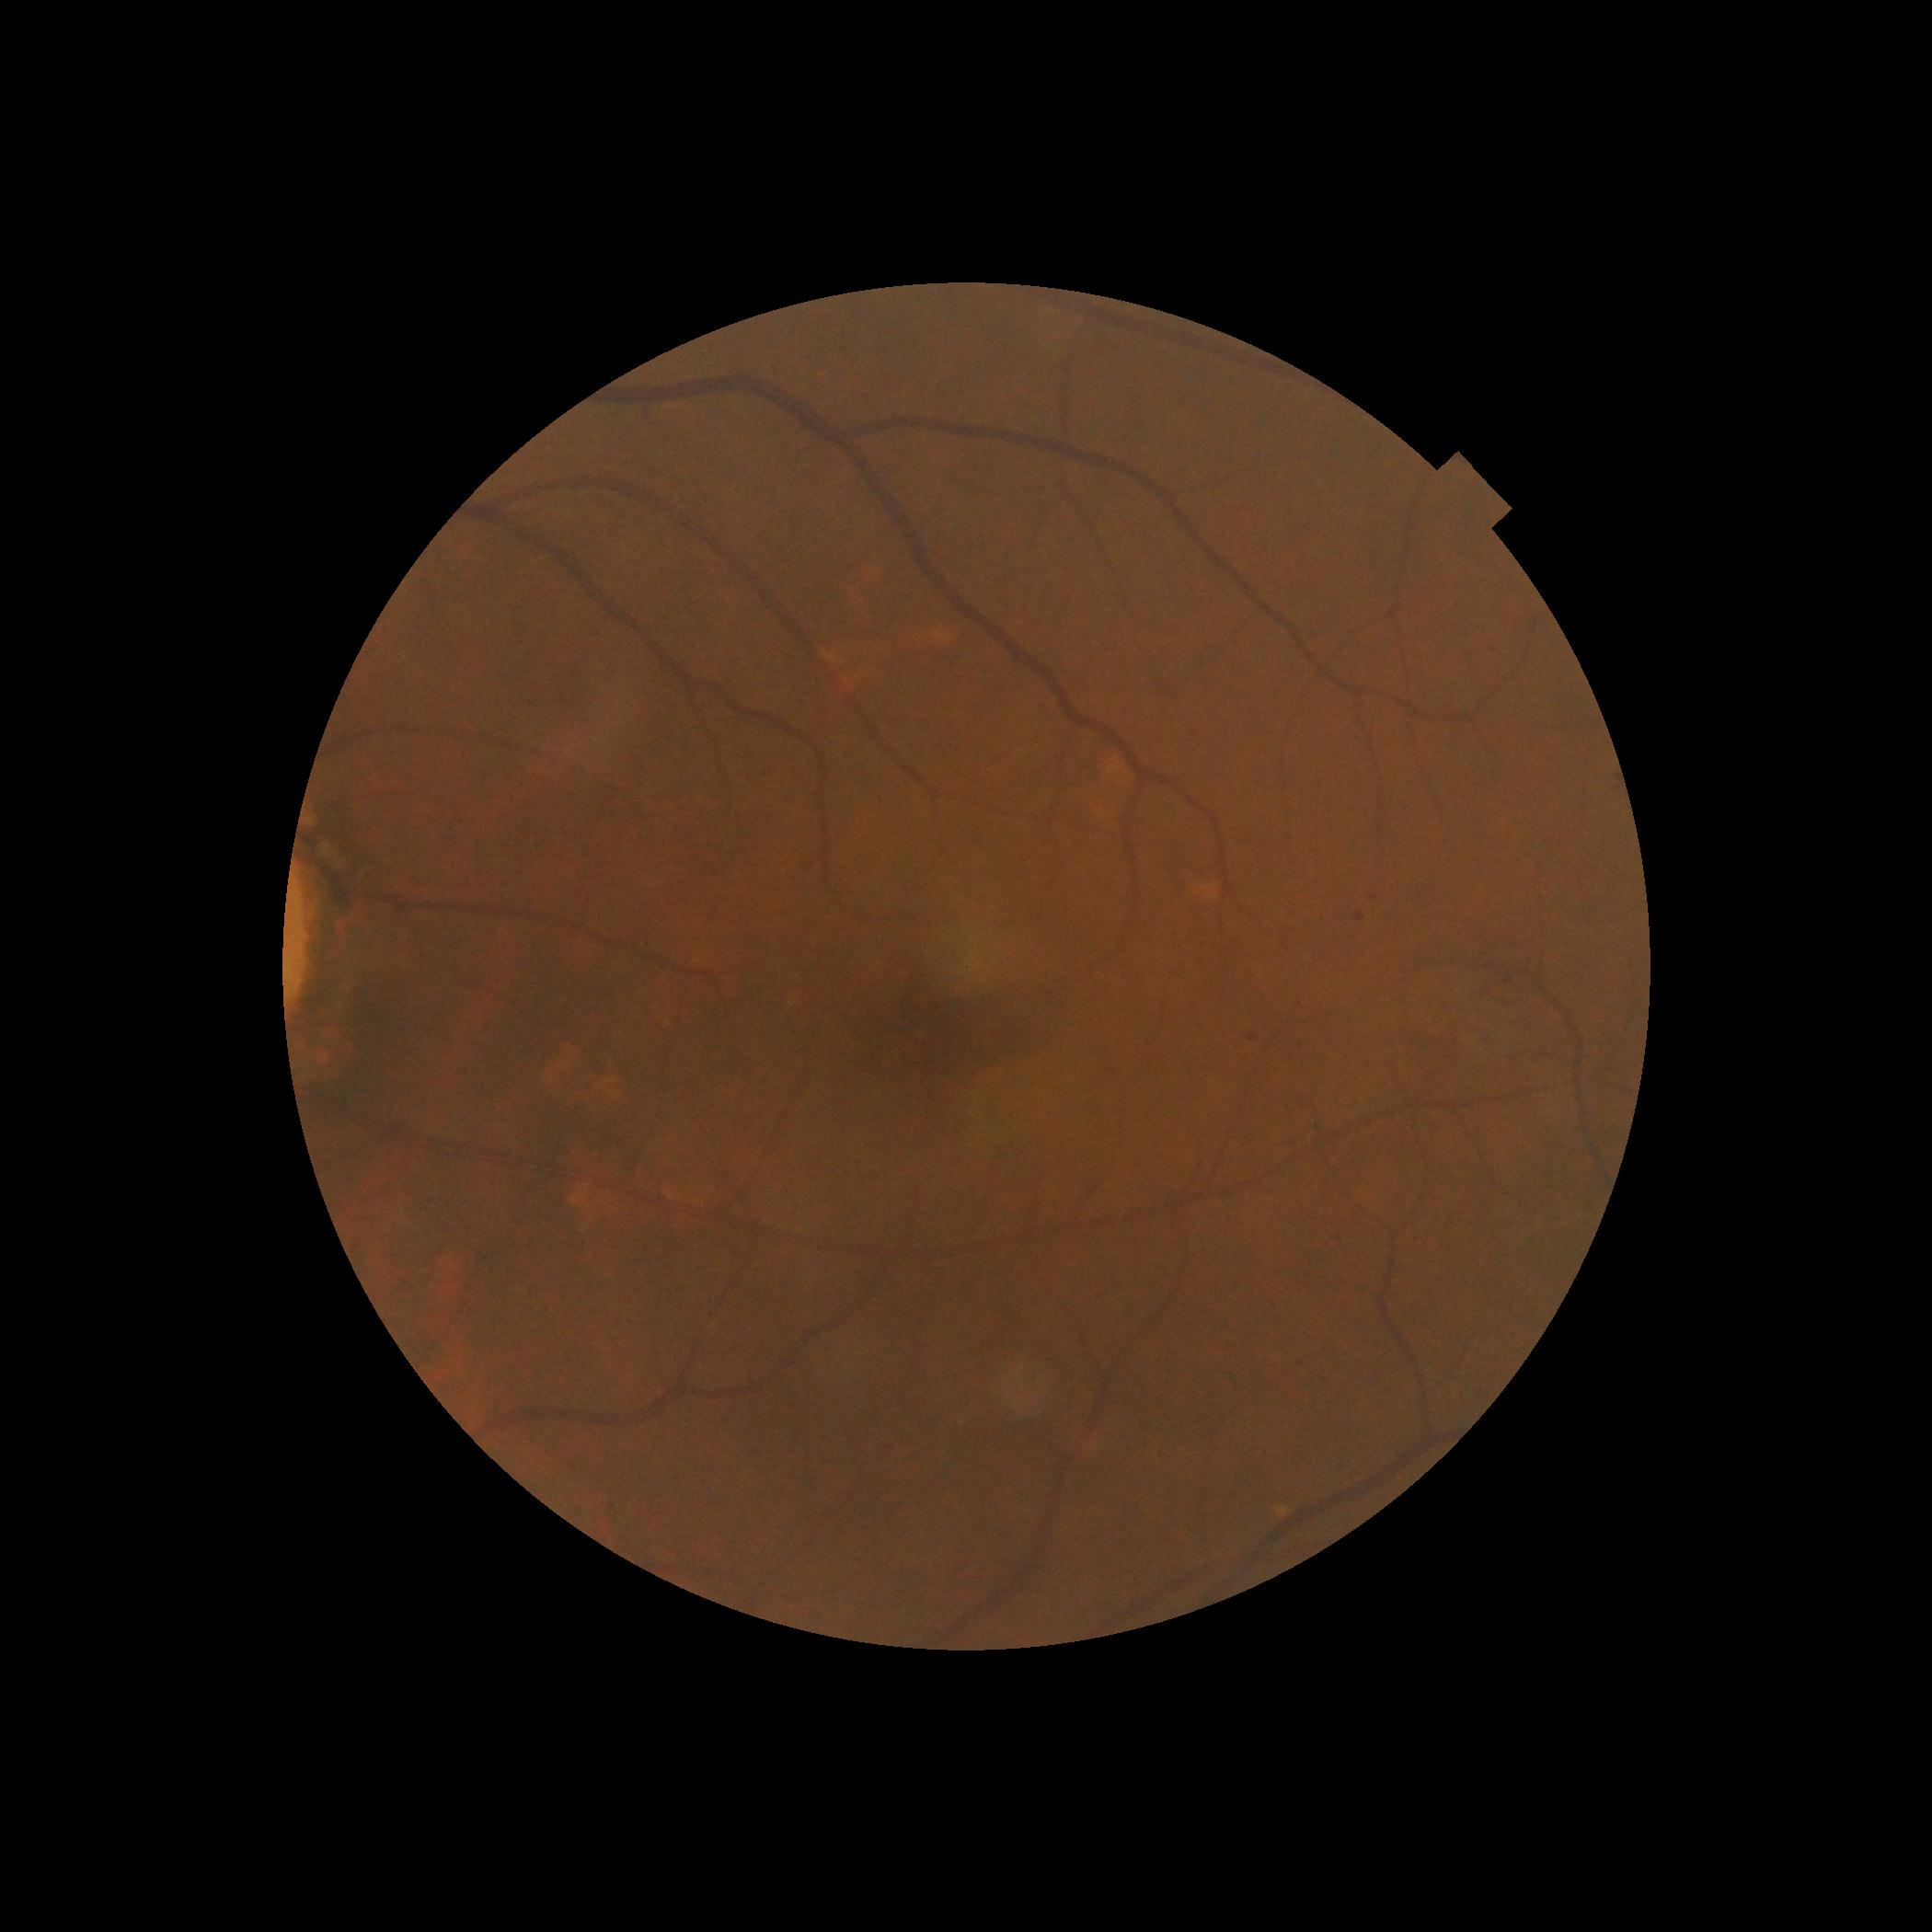
diabetic retinopathy (DR): grade 1 (mild NPDR).